45-degree field of view. Color fundus photograph. Modified Davis classification
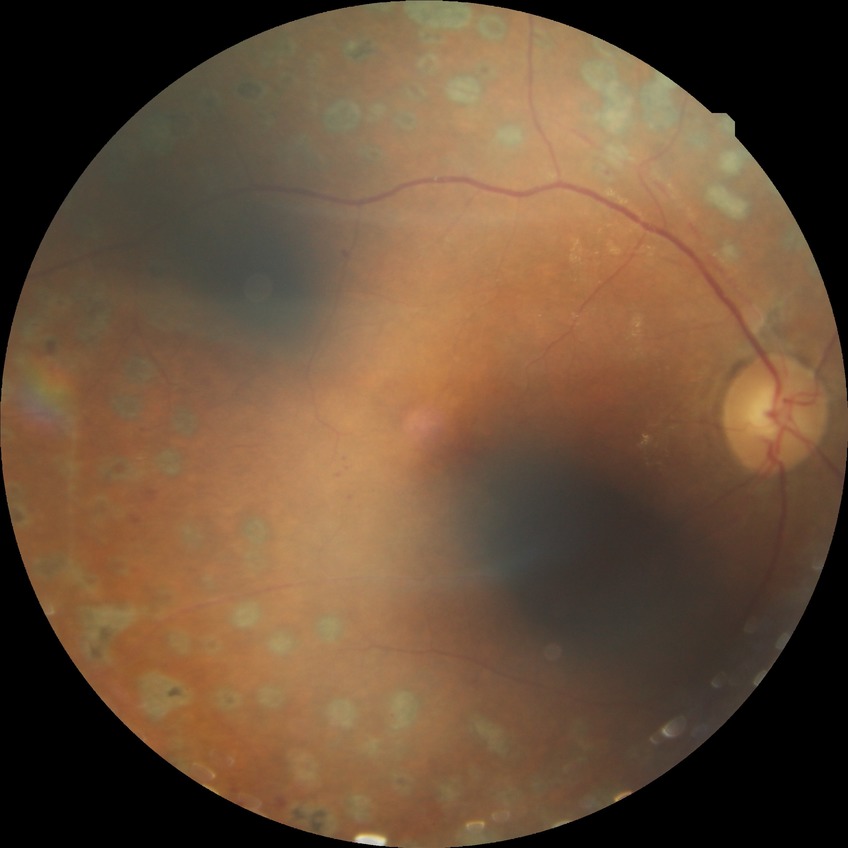

Retinopathy stage: proliferative diabetic retinopathy.